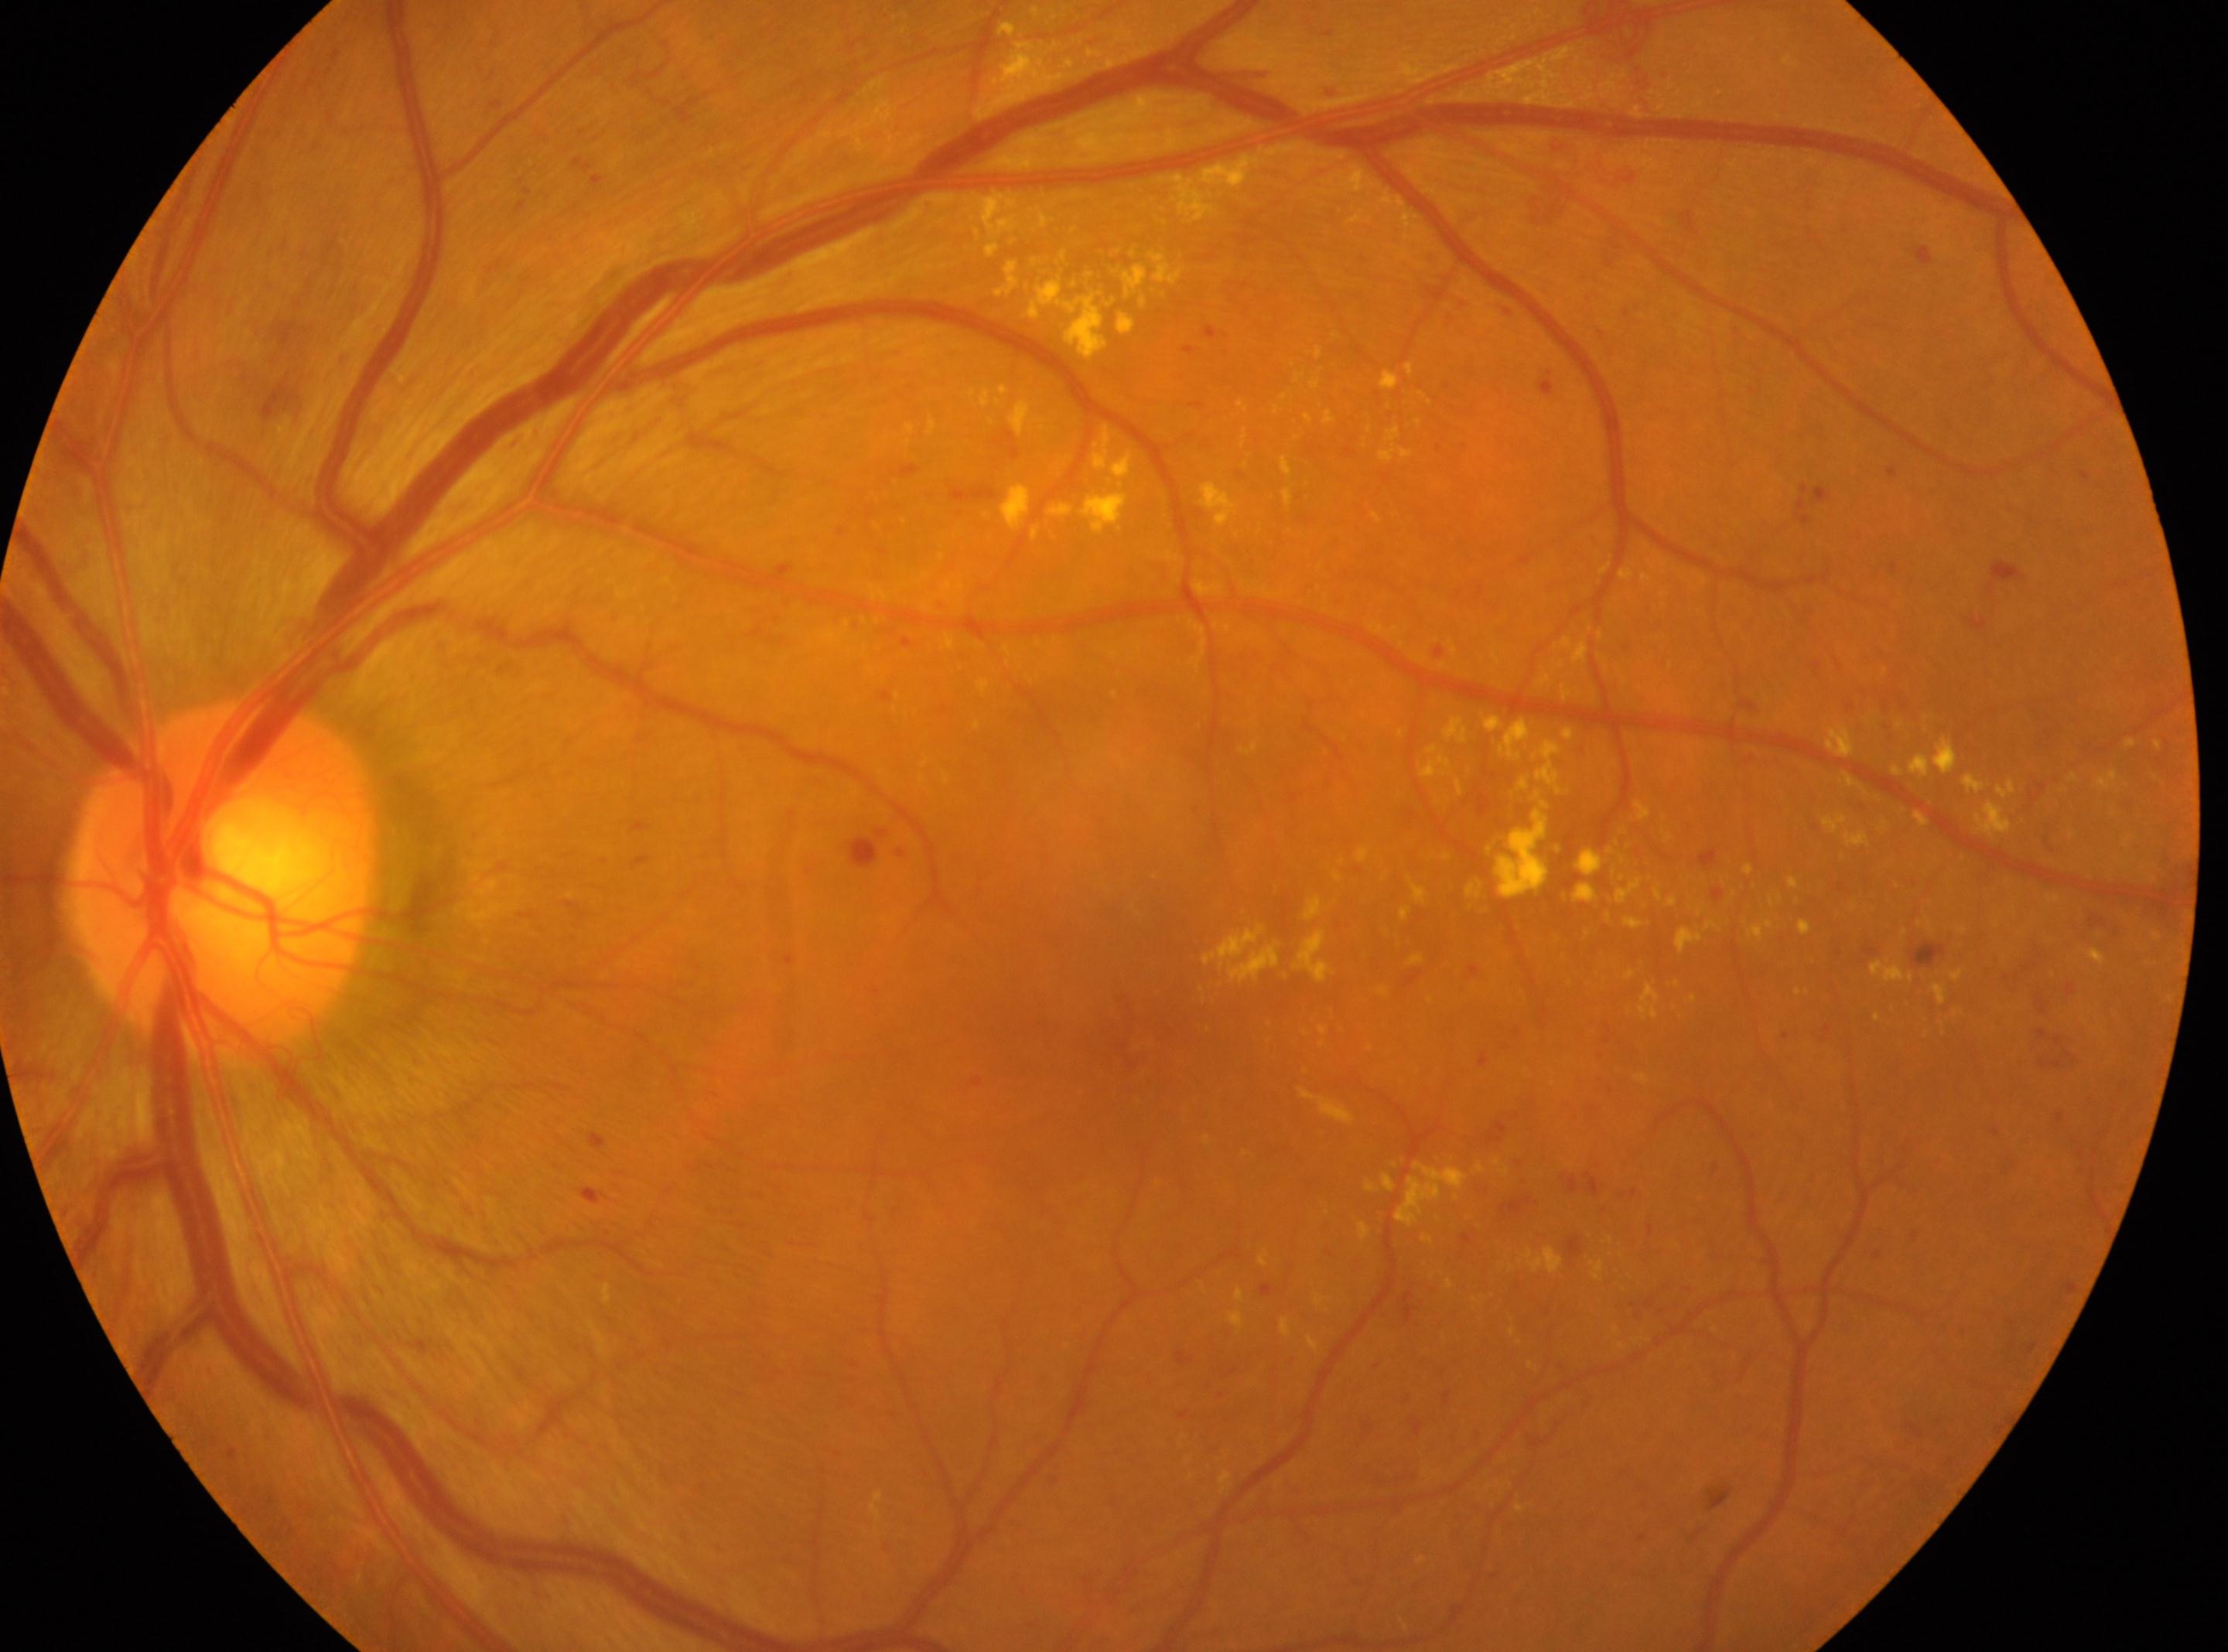
Fovea: 1145, 1044.
Optic nerve head: 224, 881.
Diabetic retinopathy (DR) is grade 3 (severe NPDR).
Eye: the left eye.